Color fundus image. 45-degree field of view
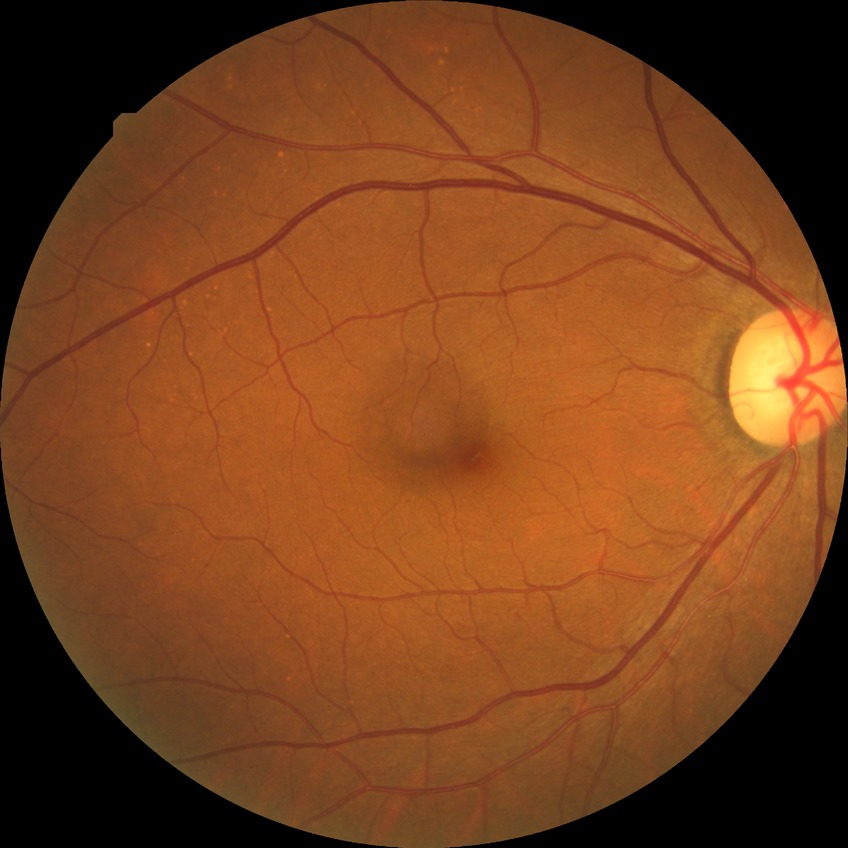 Davis stage is NDR. No apparent diabetic retinopathy.